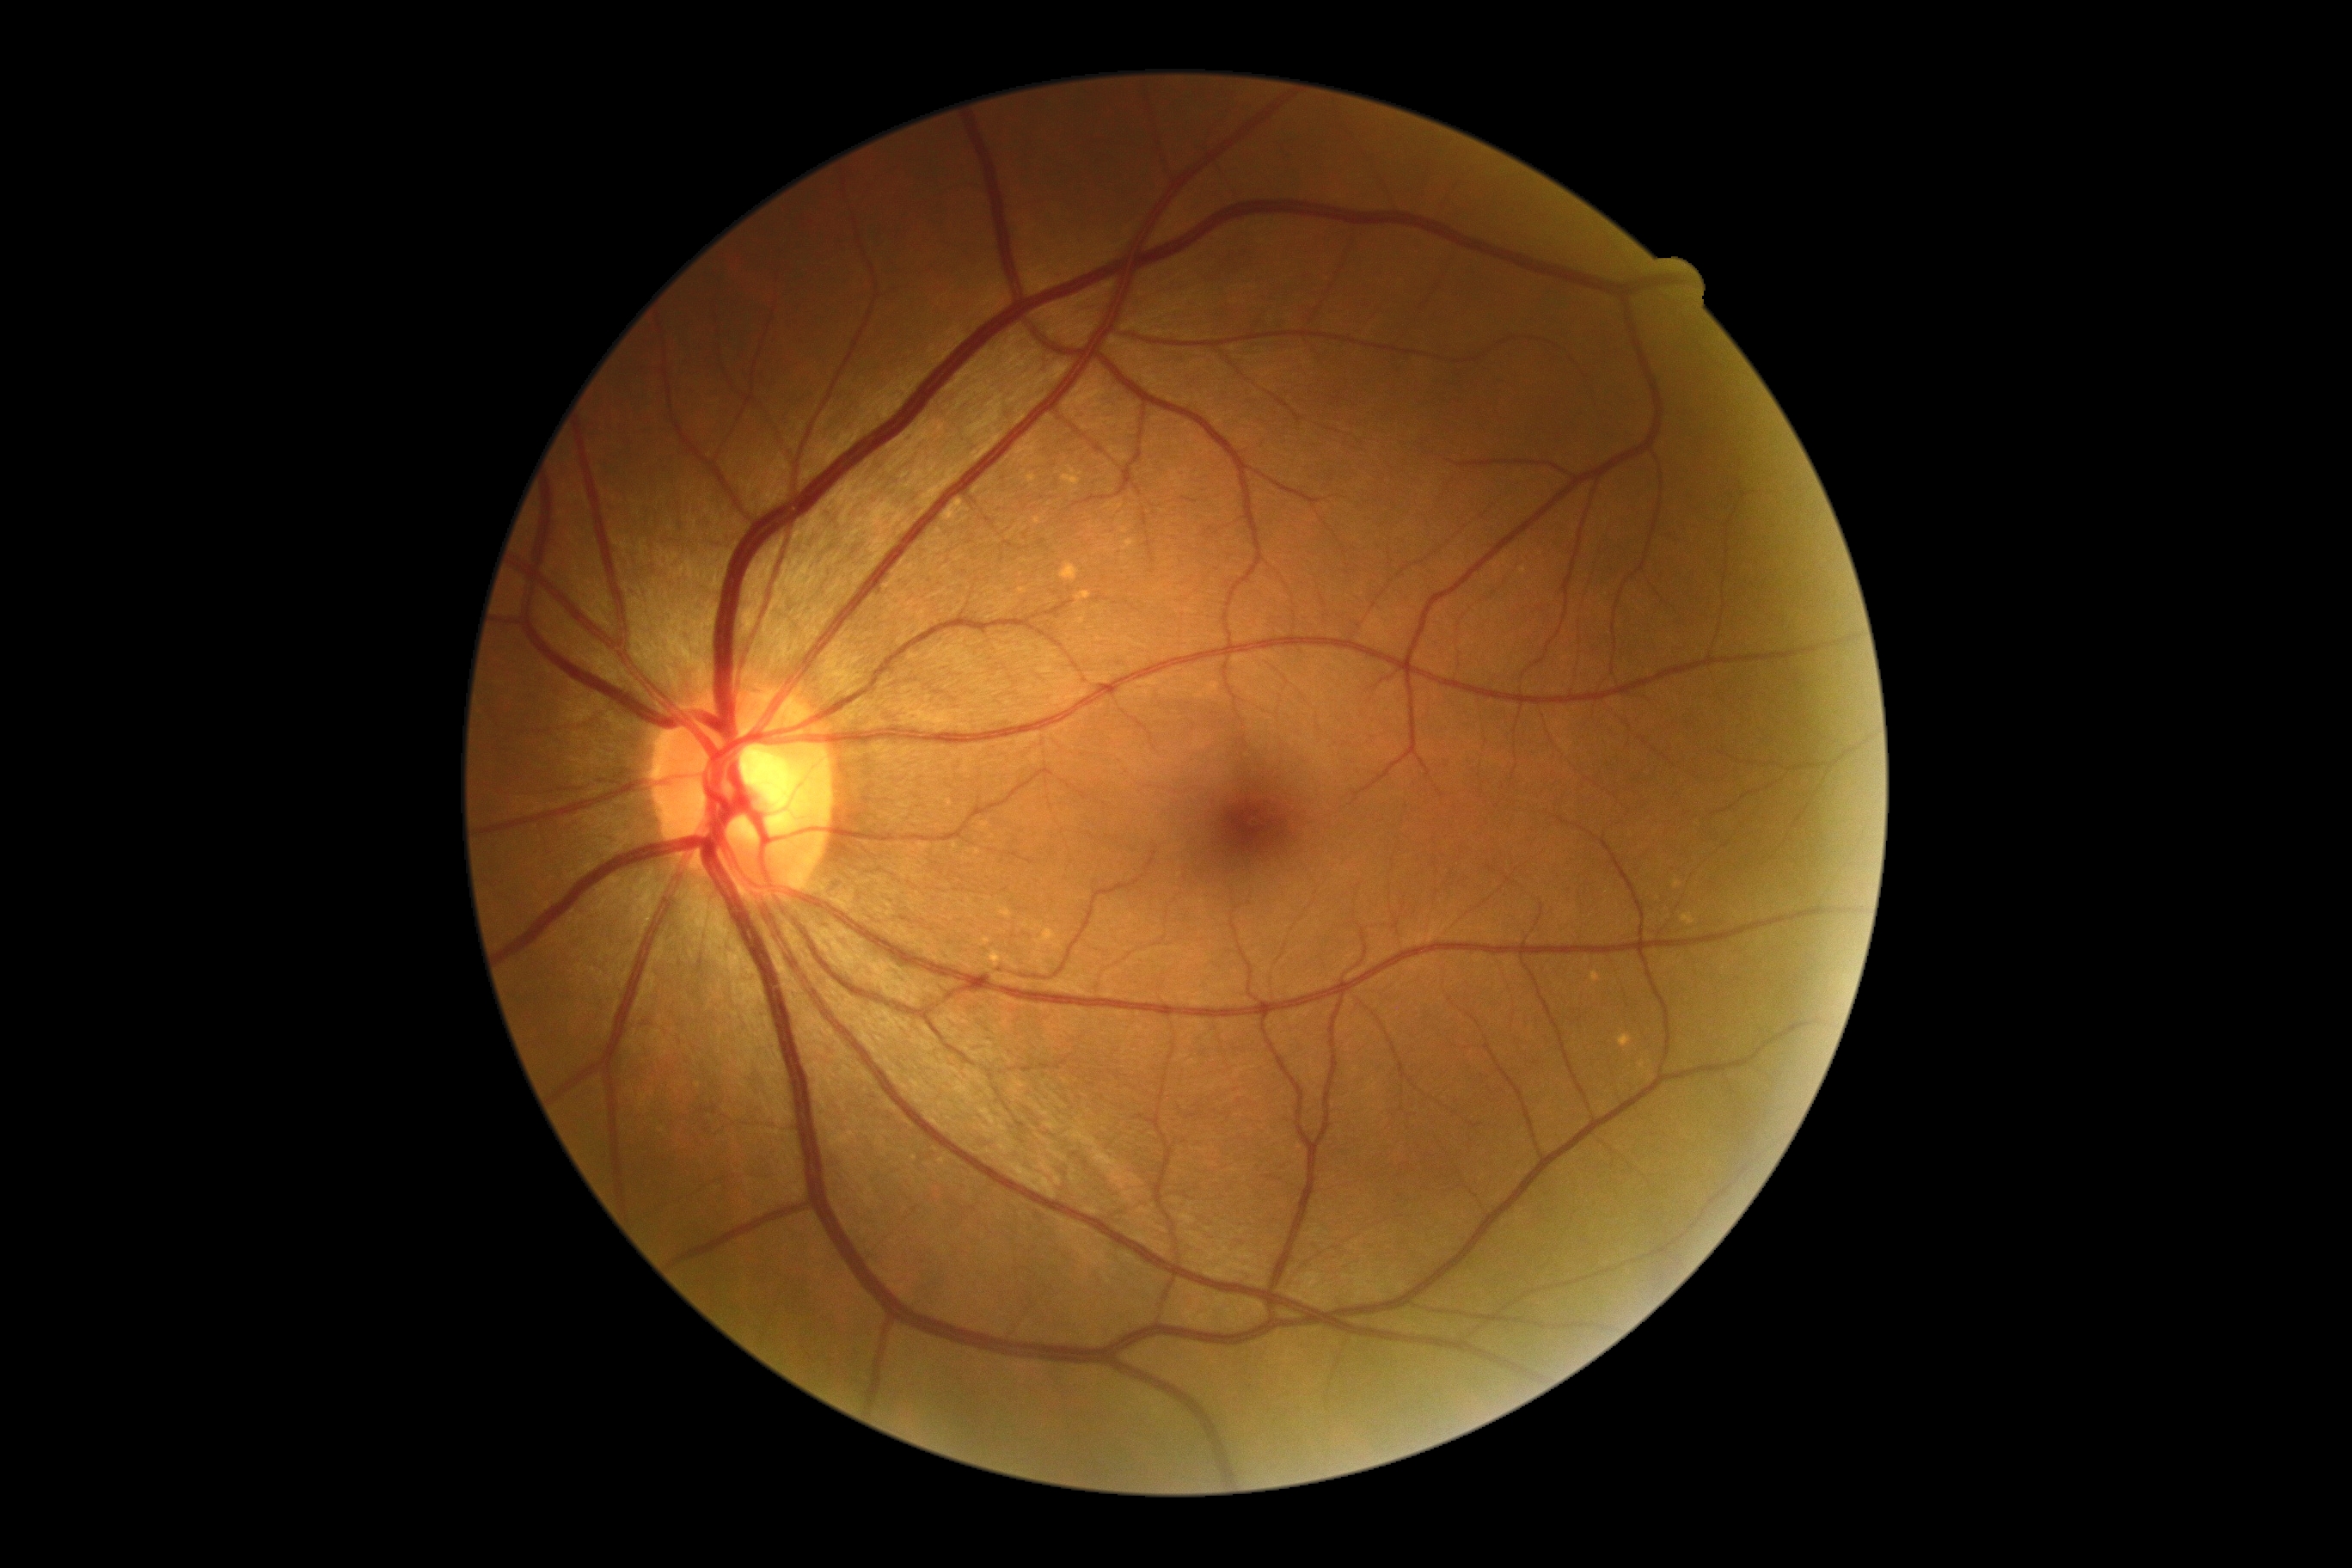

DR severity = 0/4